Graded on the modified Davis scale: 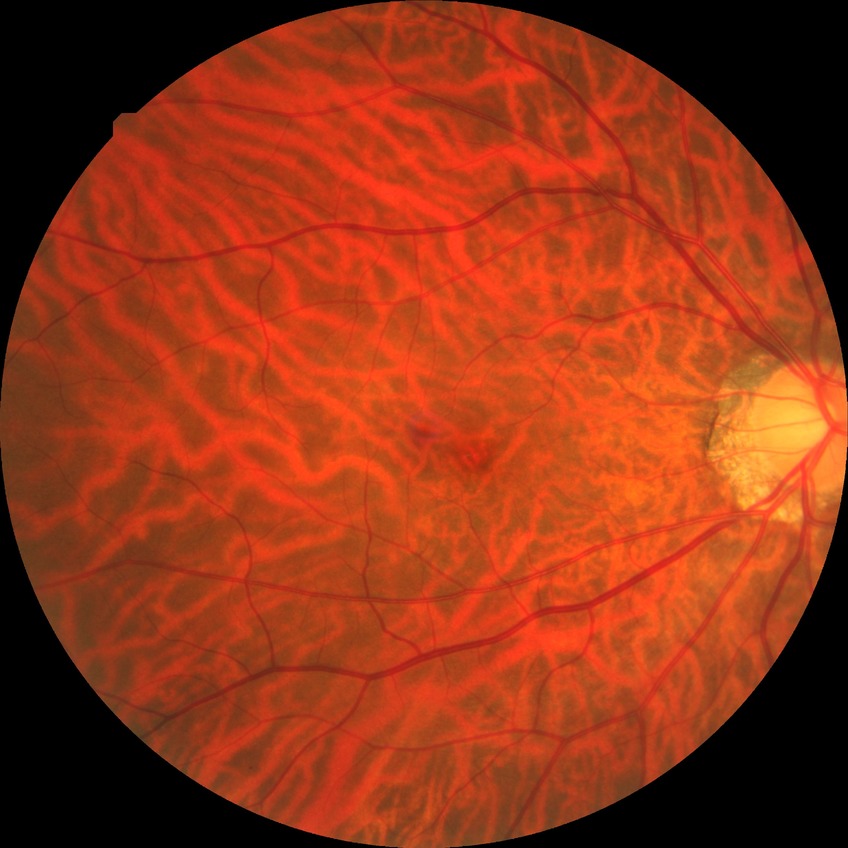
DR severity: NDR.